UWF retinal mosaic. 1924 by 1556 pixels — 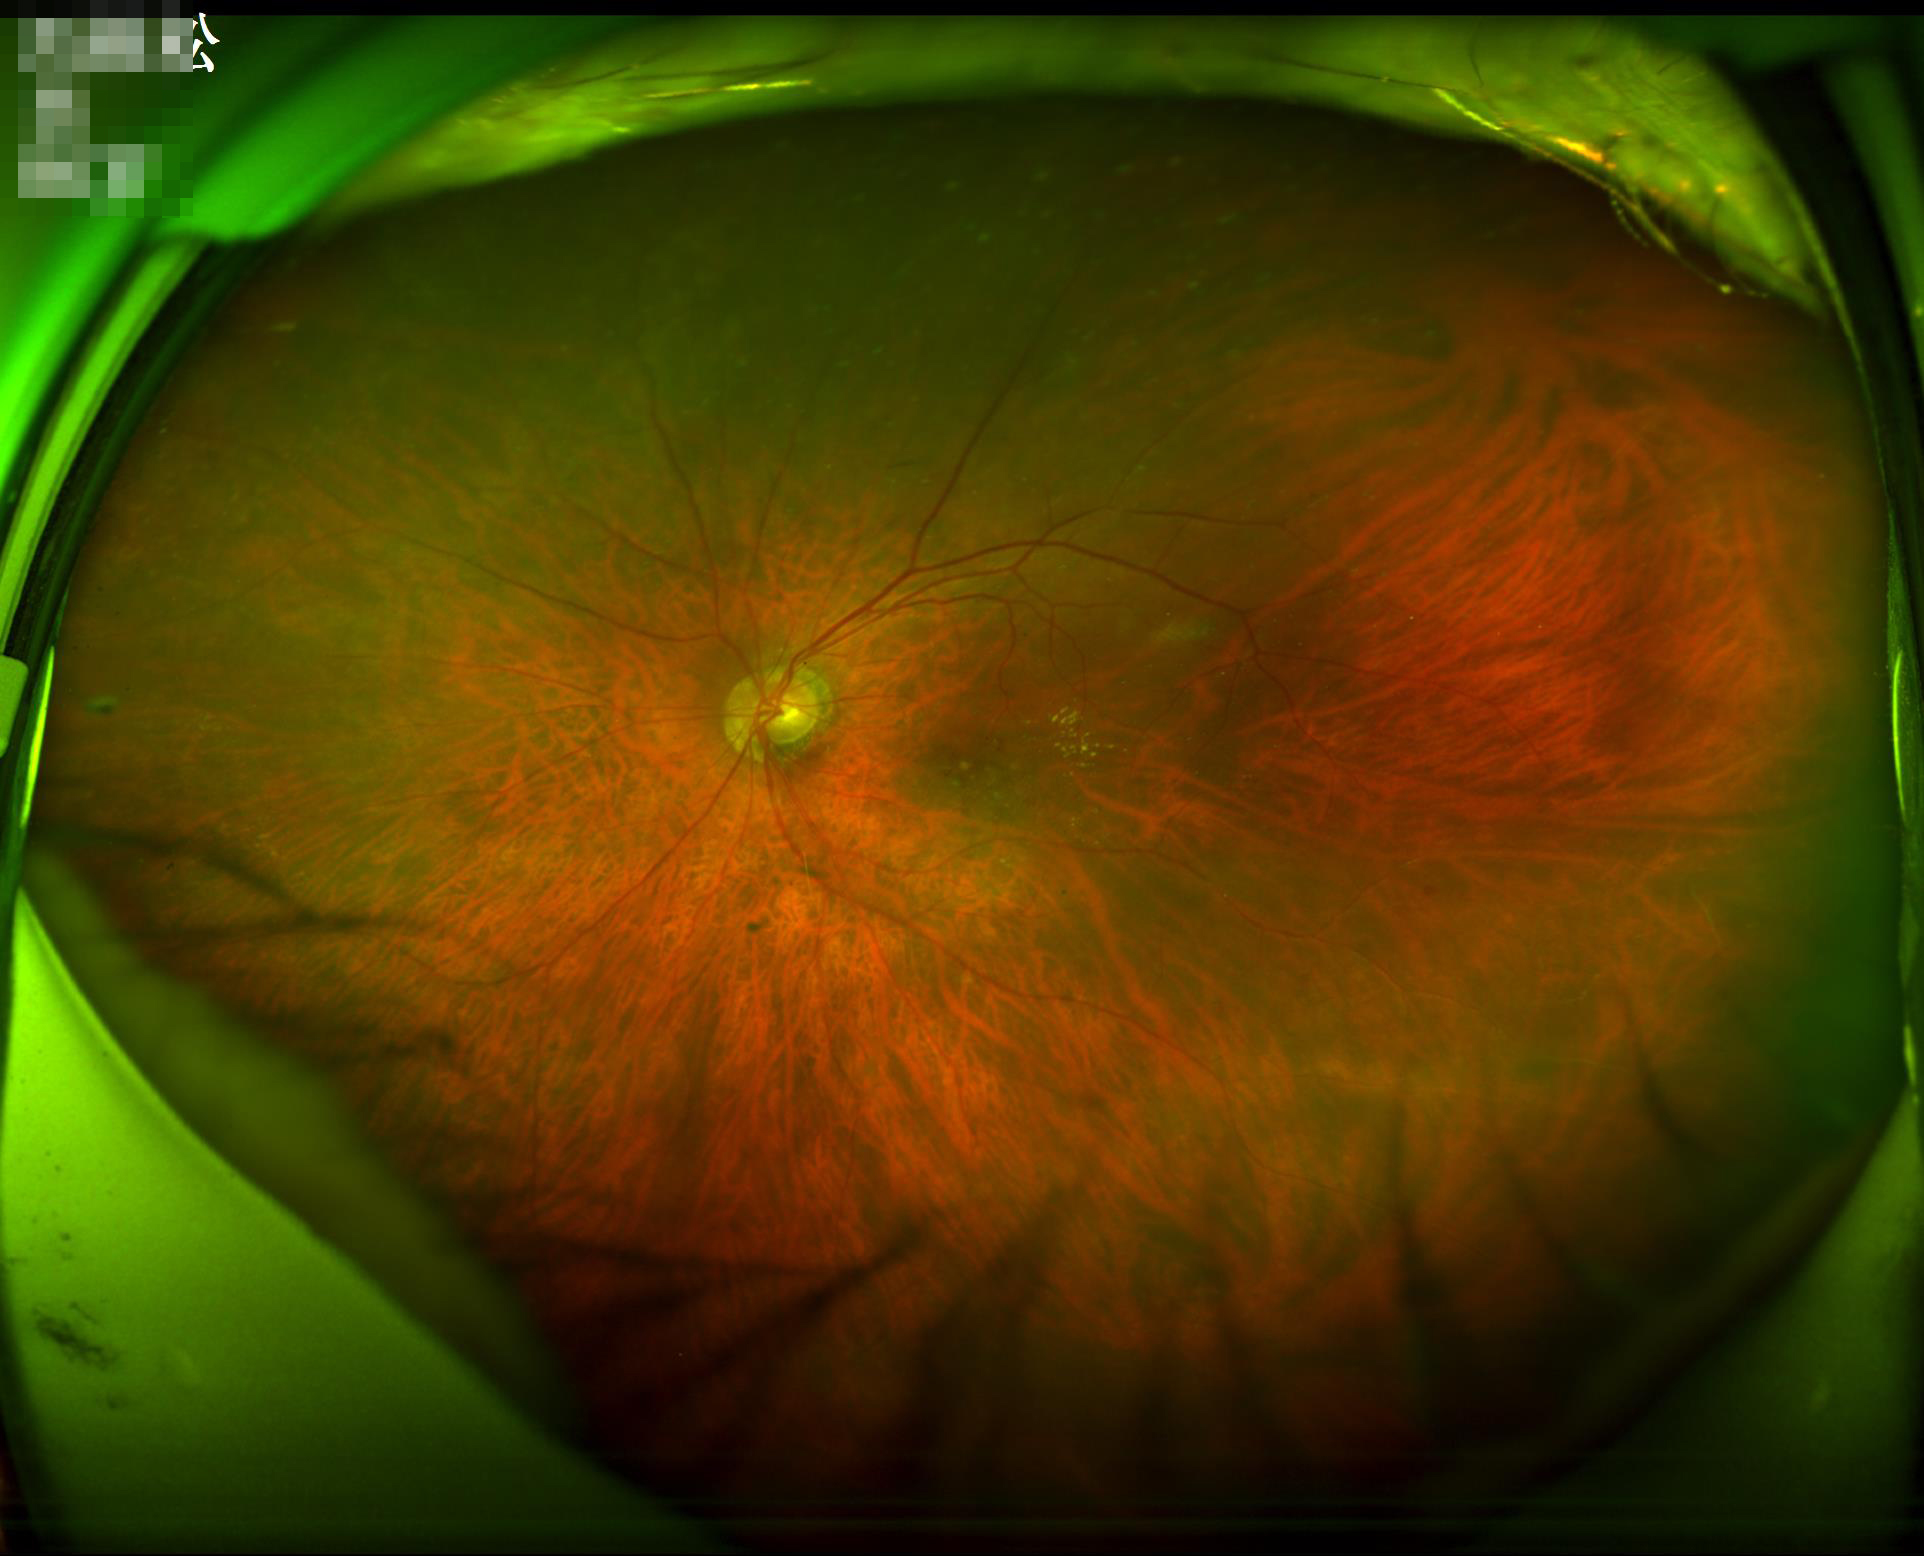 Overall quality is good and the image is gradable. Image is sharp throughout the field. Adequate contrast for distinguishing structures. Even illumination with no color cast.